45° FOV · fundus photo · image size 2212x1659
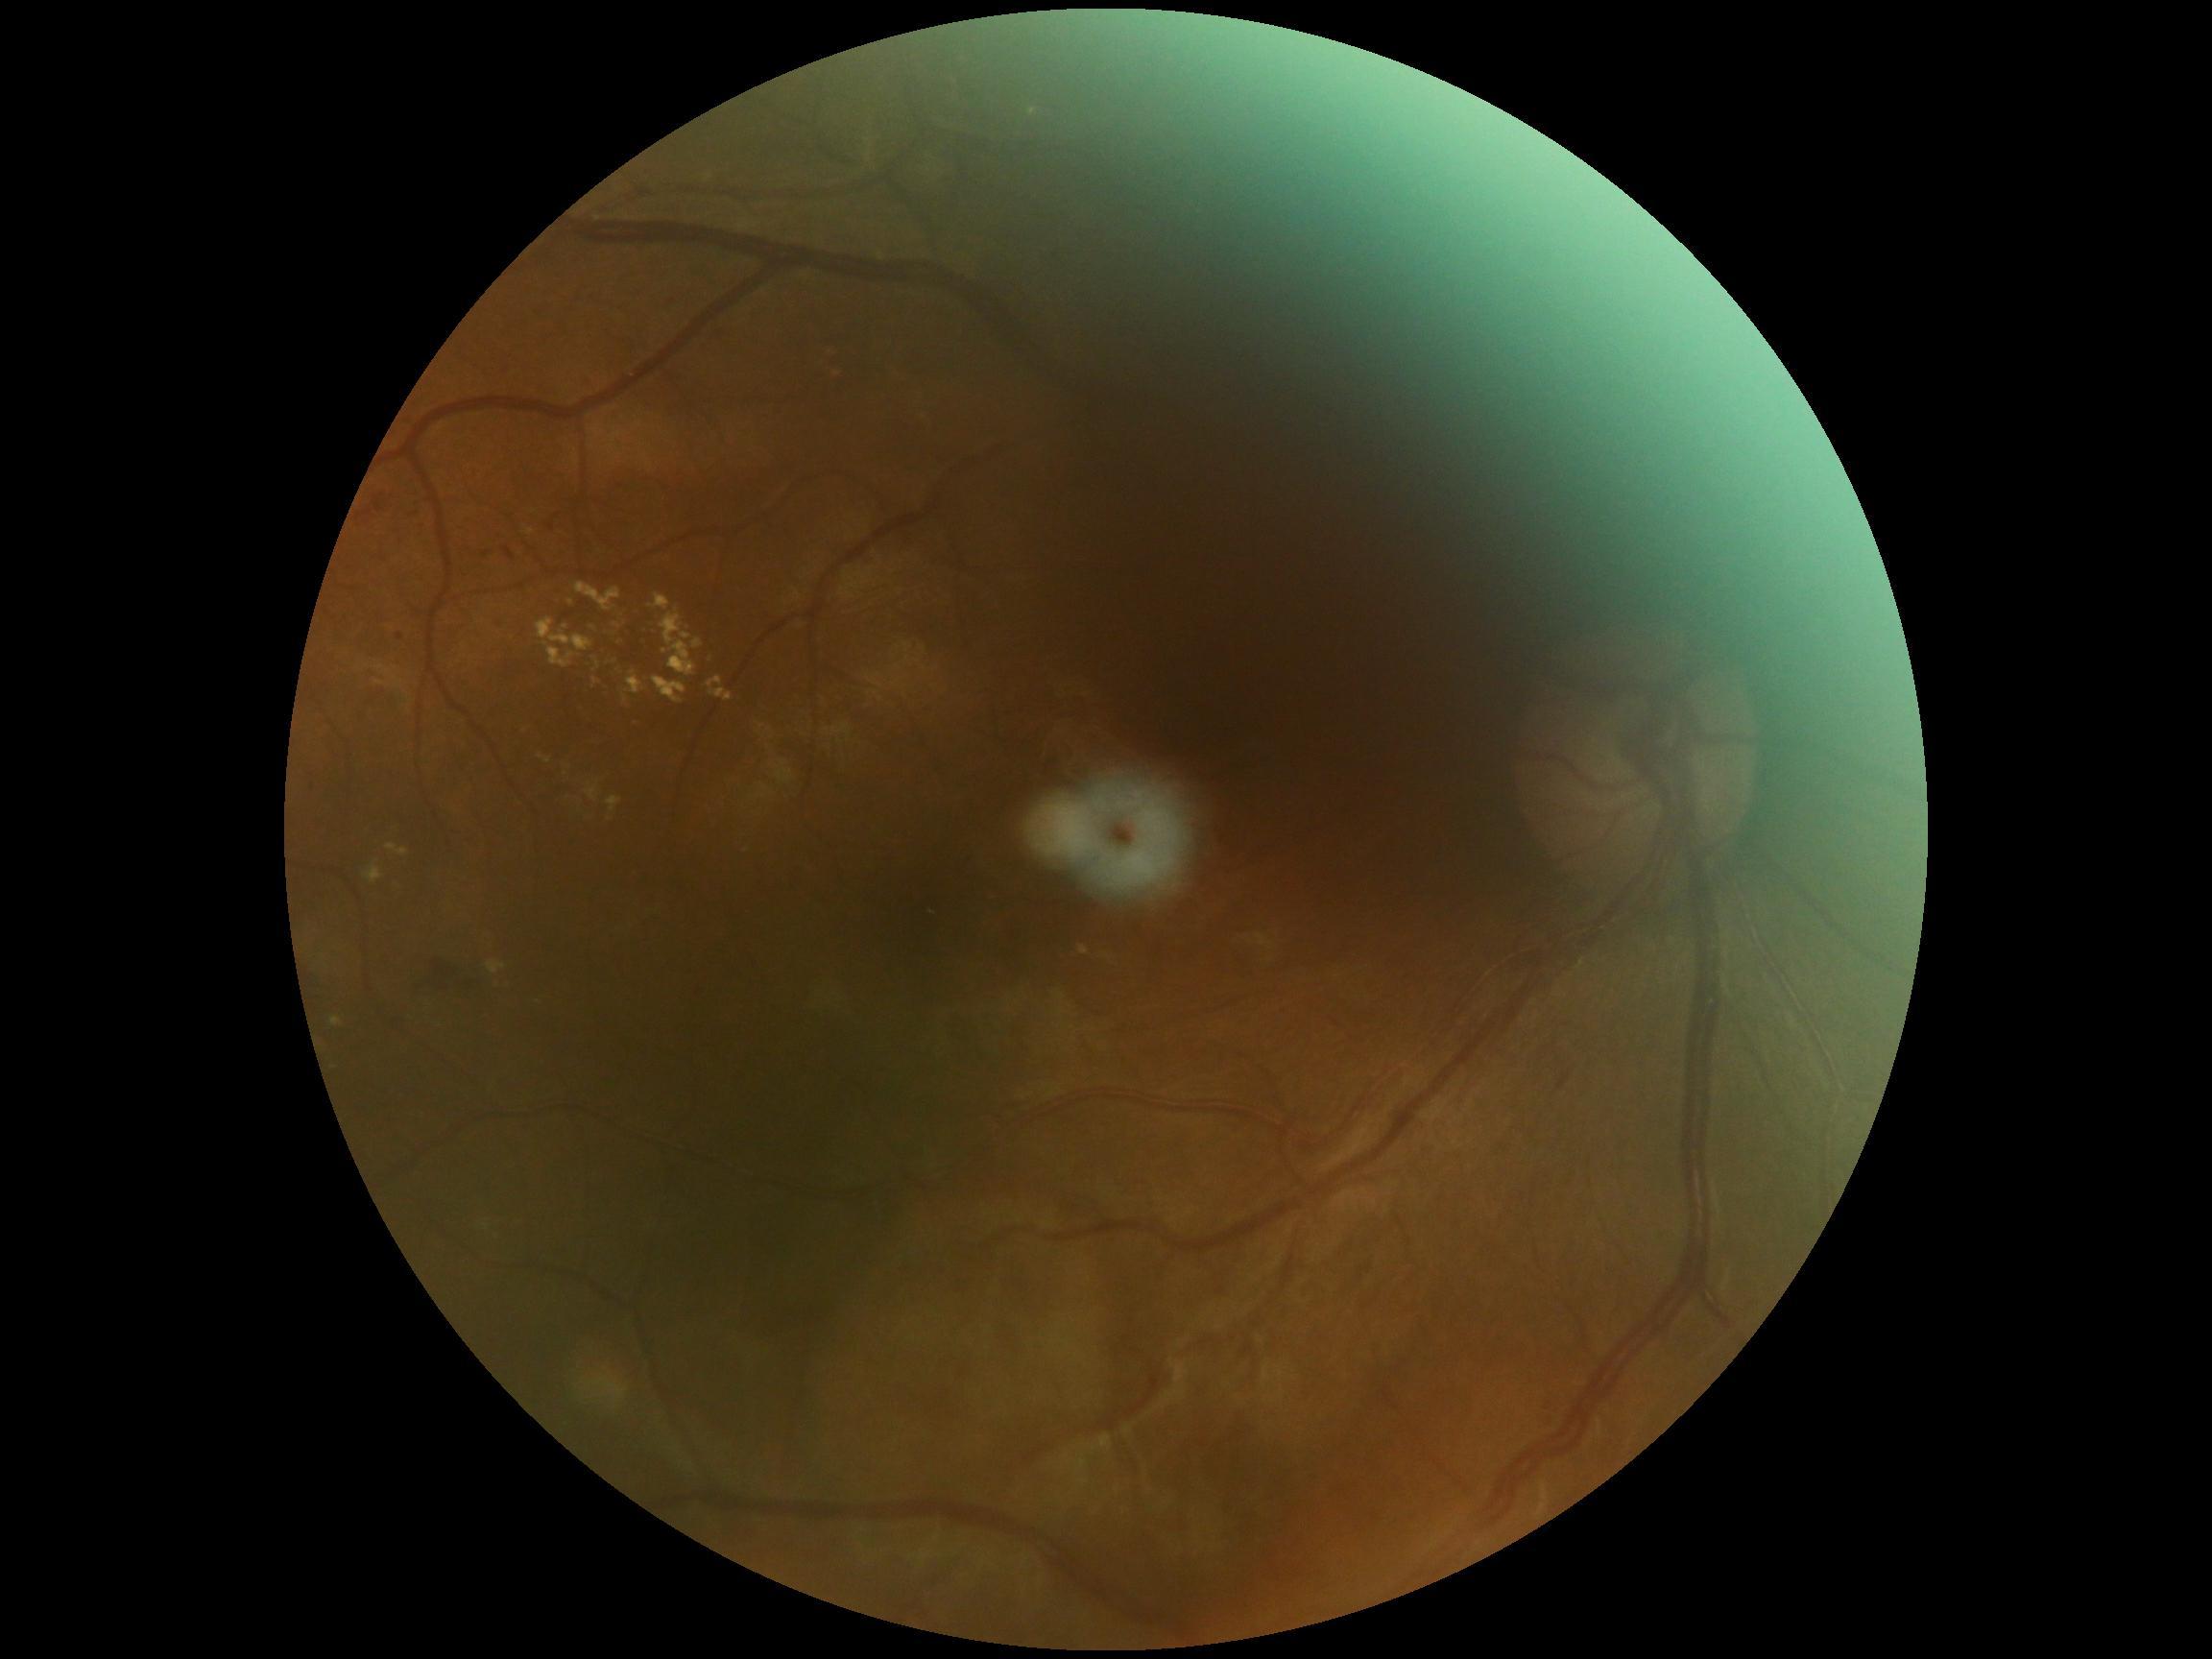
Diabetic retinopathy is grade 2 (moderate NPDR) — more than just microaneurysms but less than severe NPDR.
DR class: non-proliferative diabetic retinopathy.